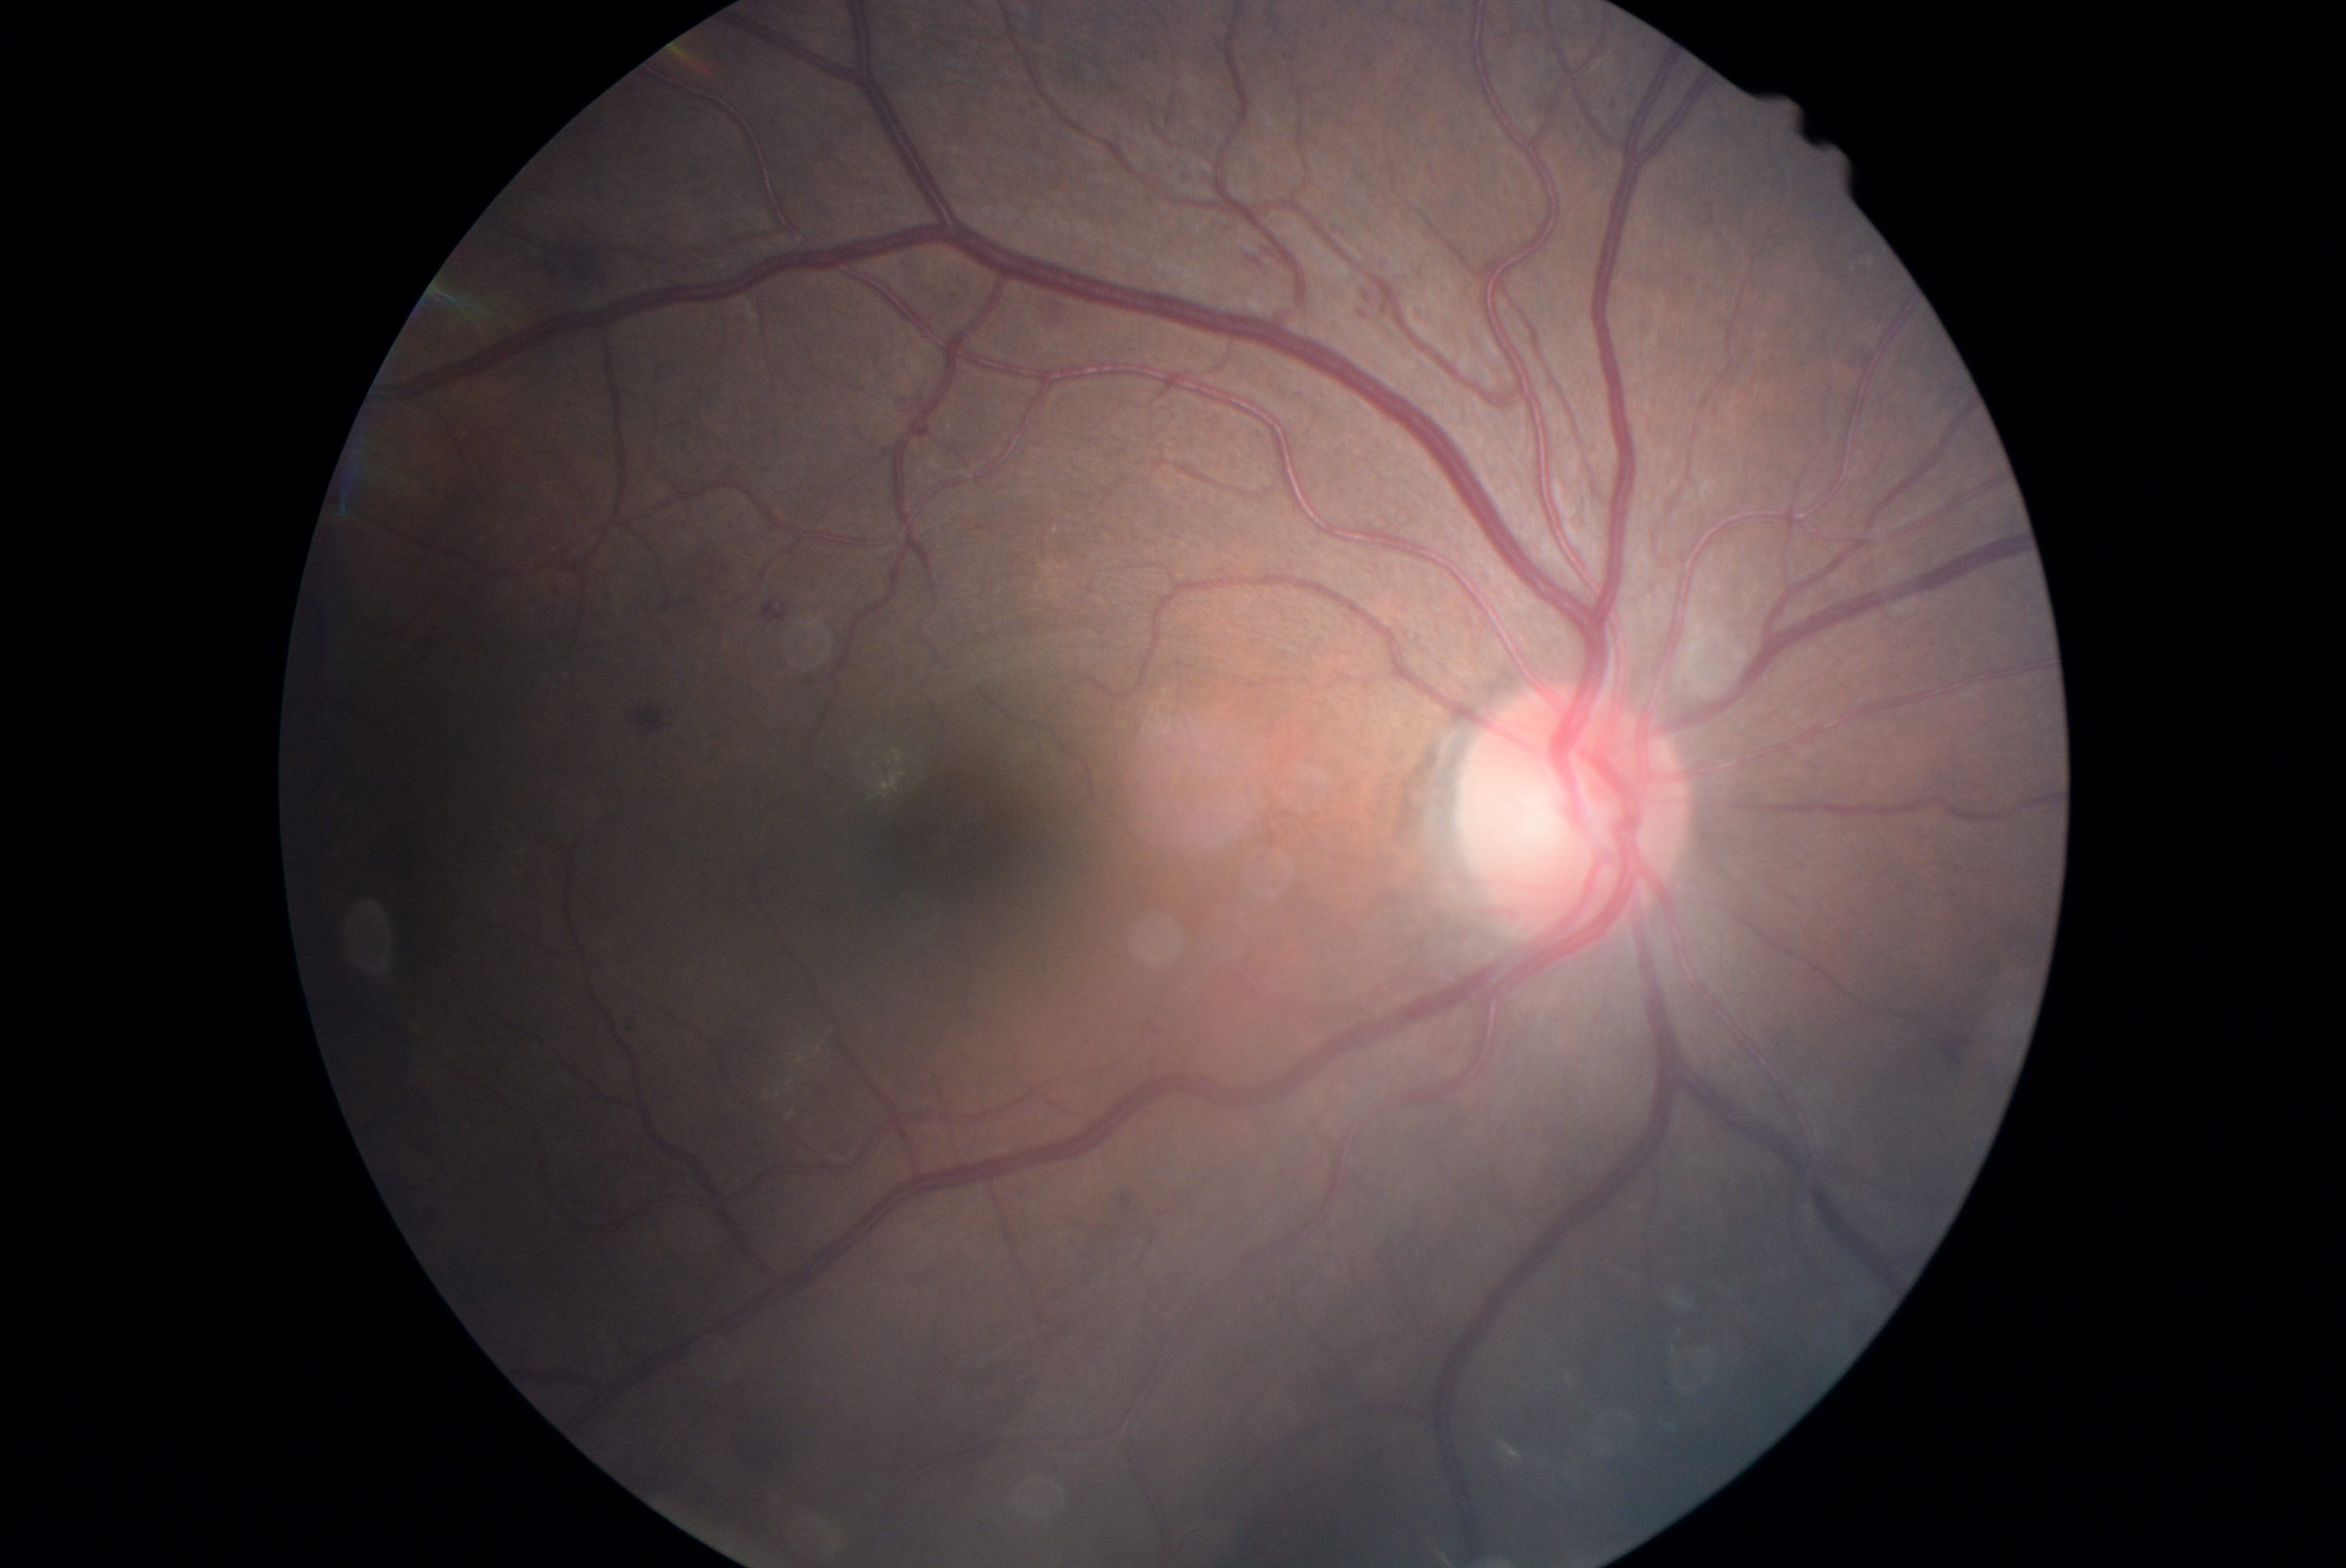

DR class: non-proliferative diabetic retinopathy, diabetic retinopathy: grade 2 (moderate NPDR).